1659x2212; CFP; captured on a Remidio Fundus on Phone — 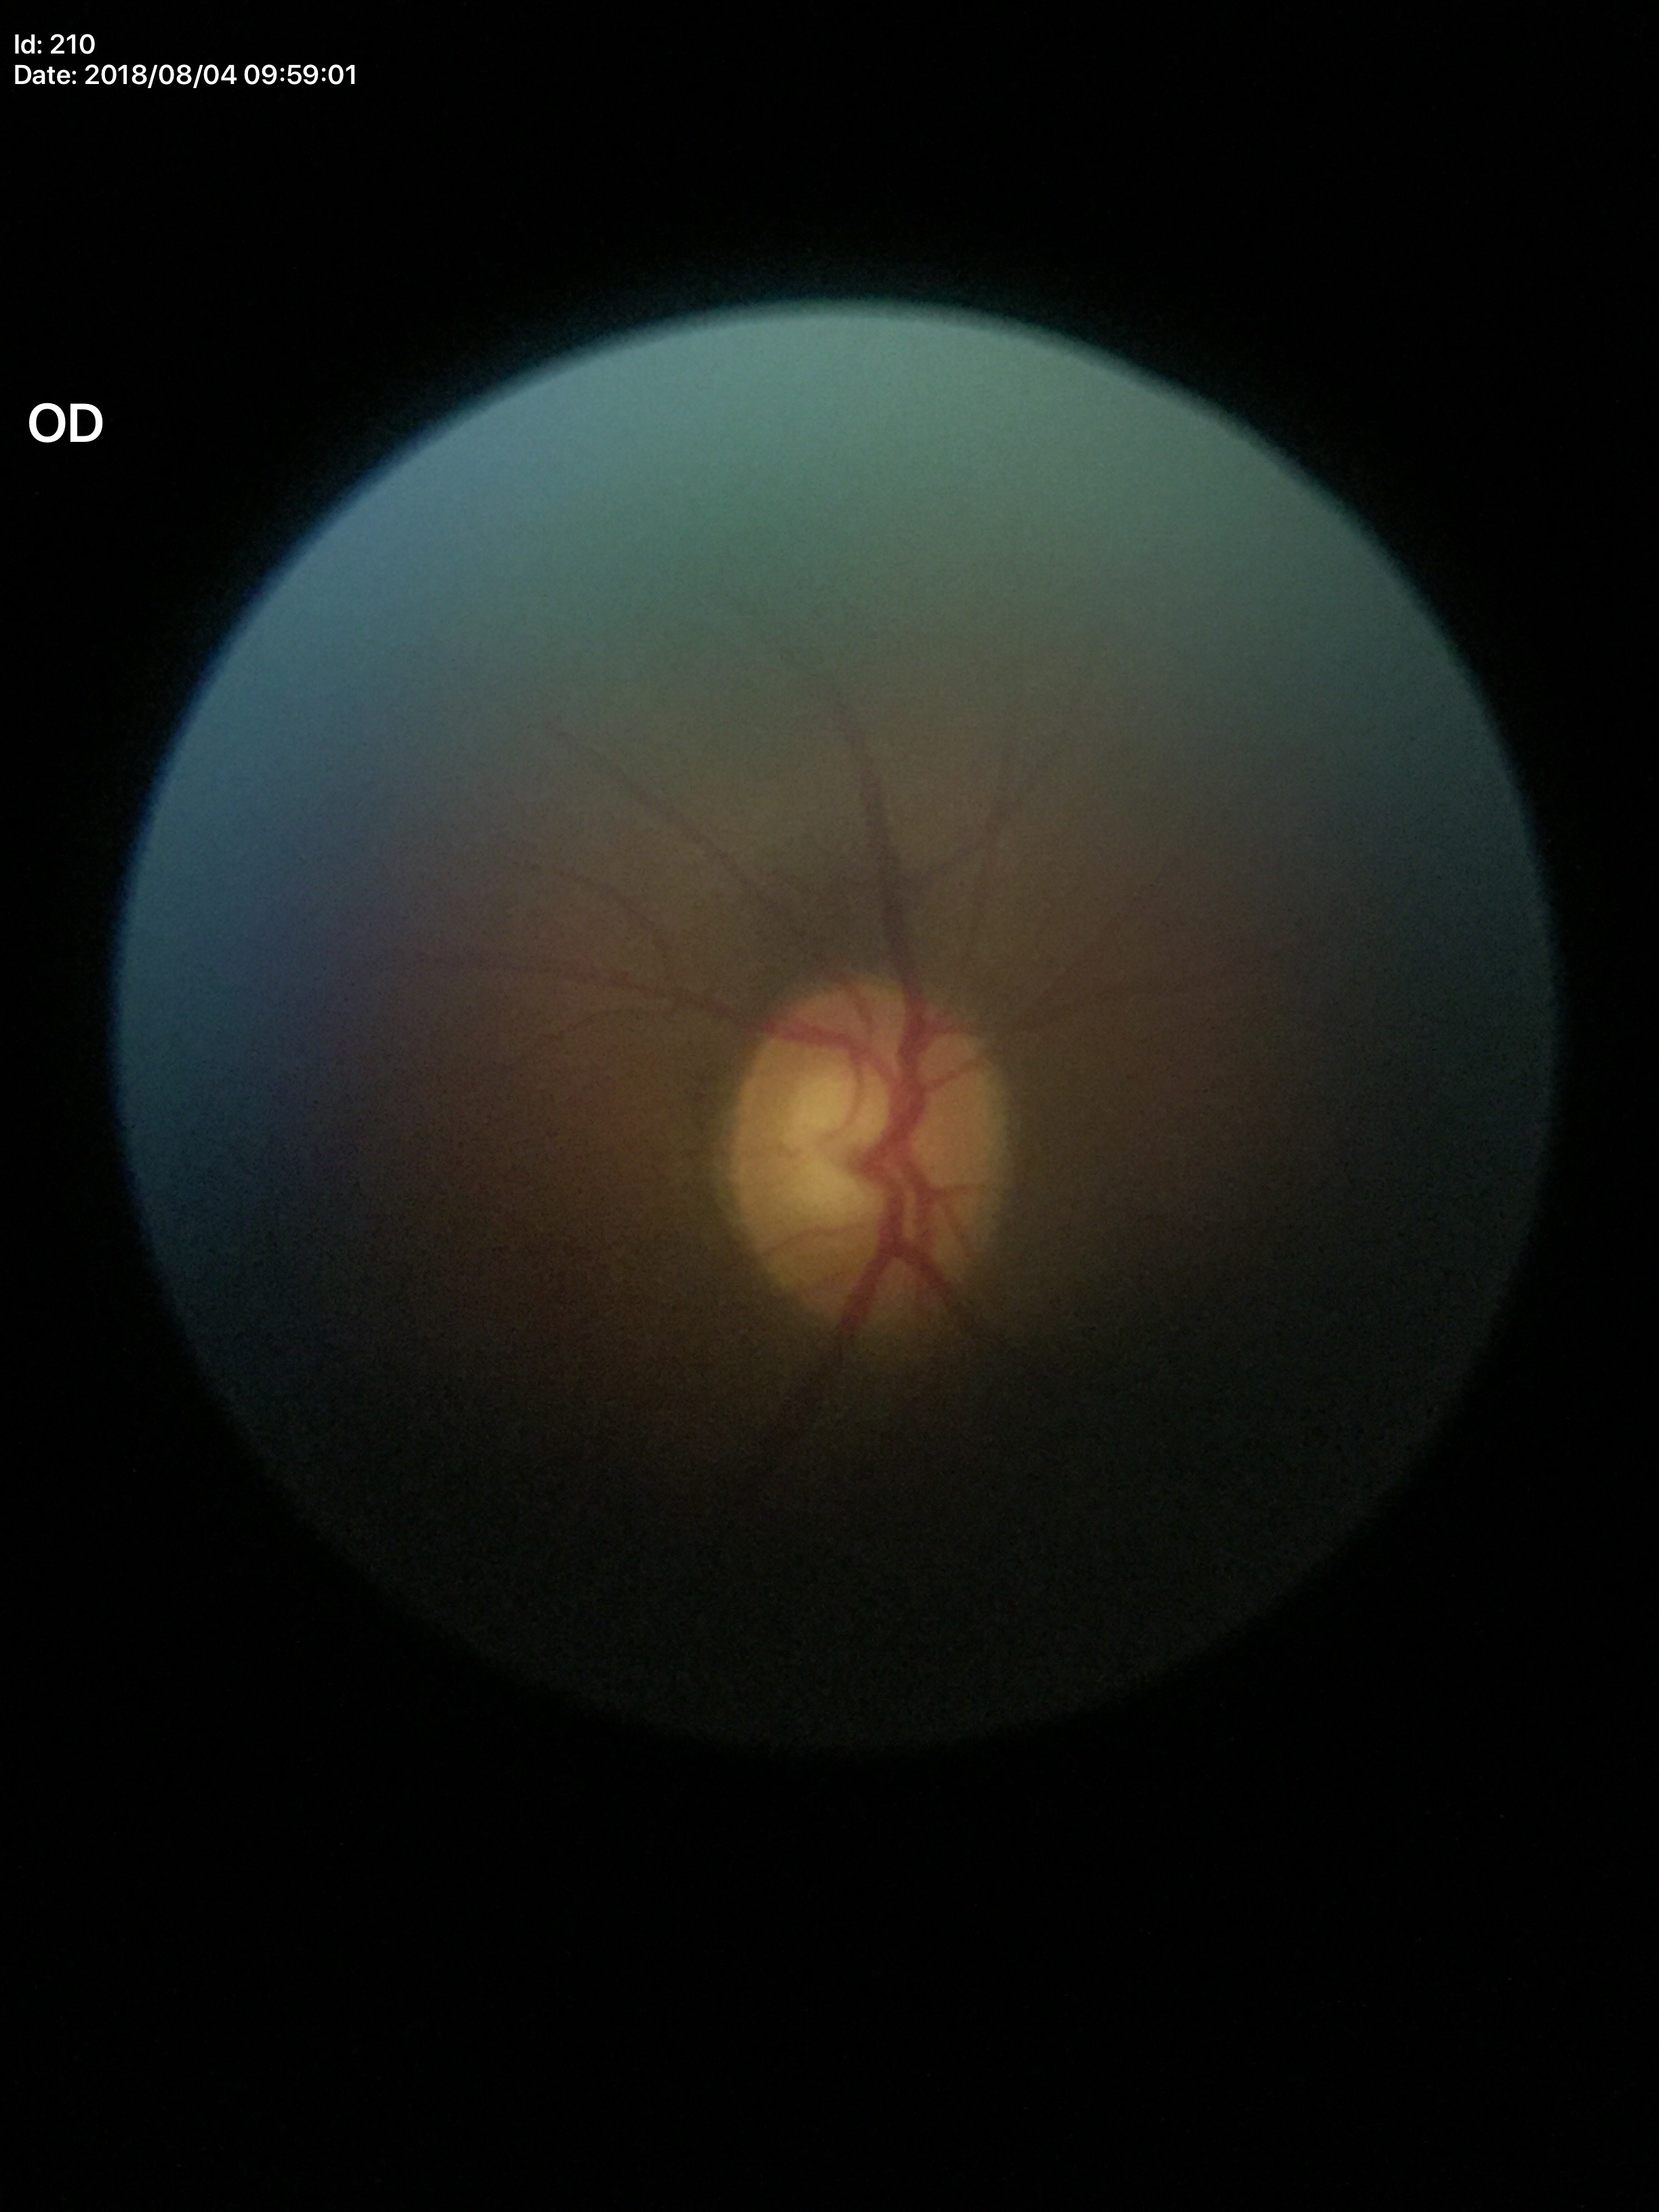

No evidence of glaucoma. Vertical CDR is 0.58.